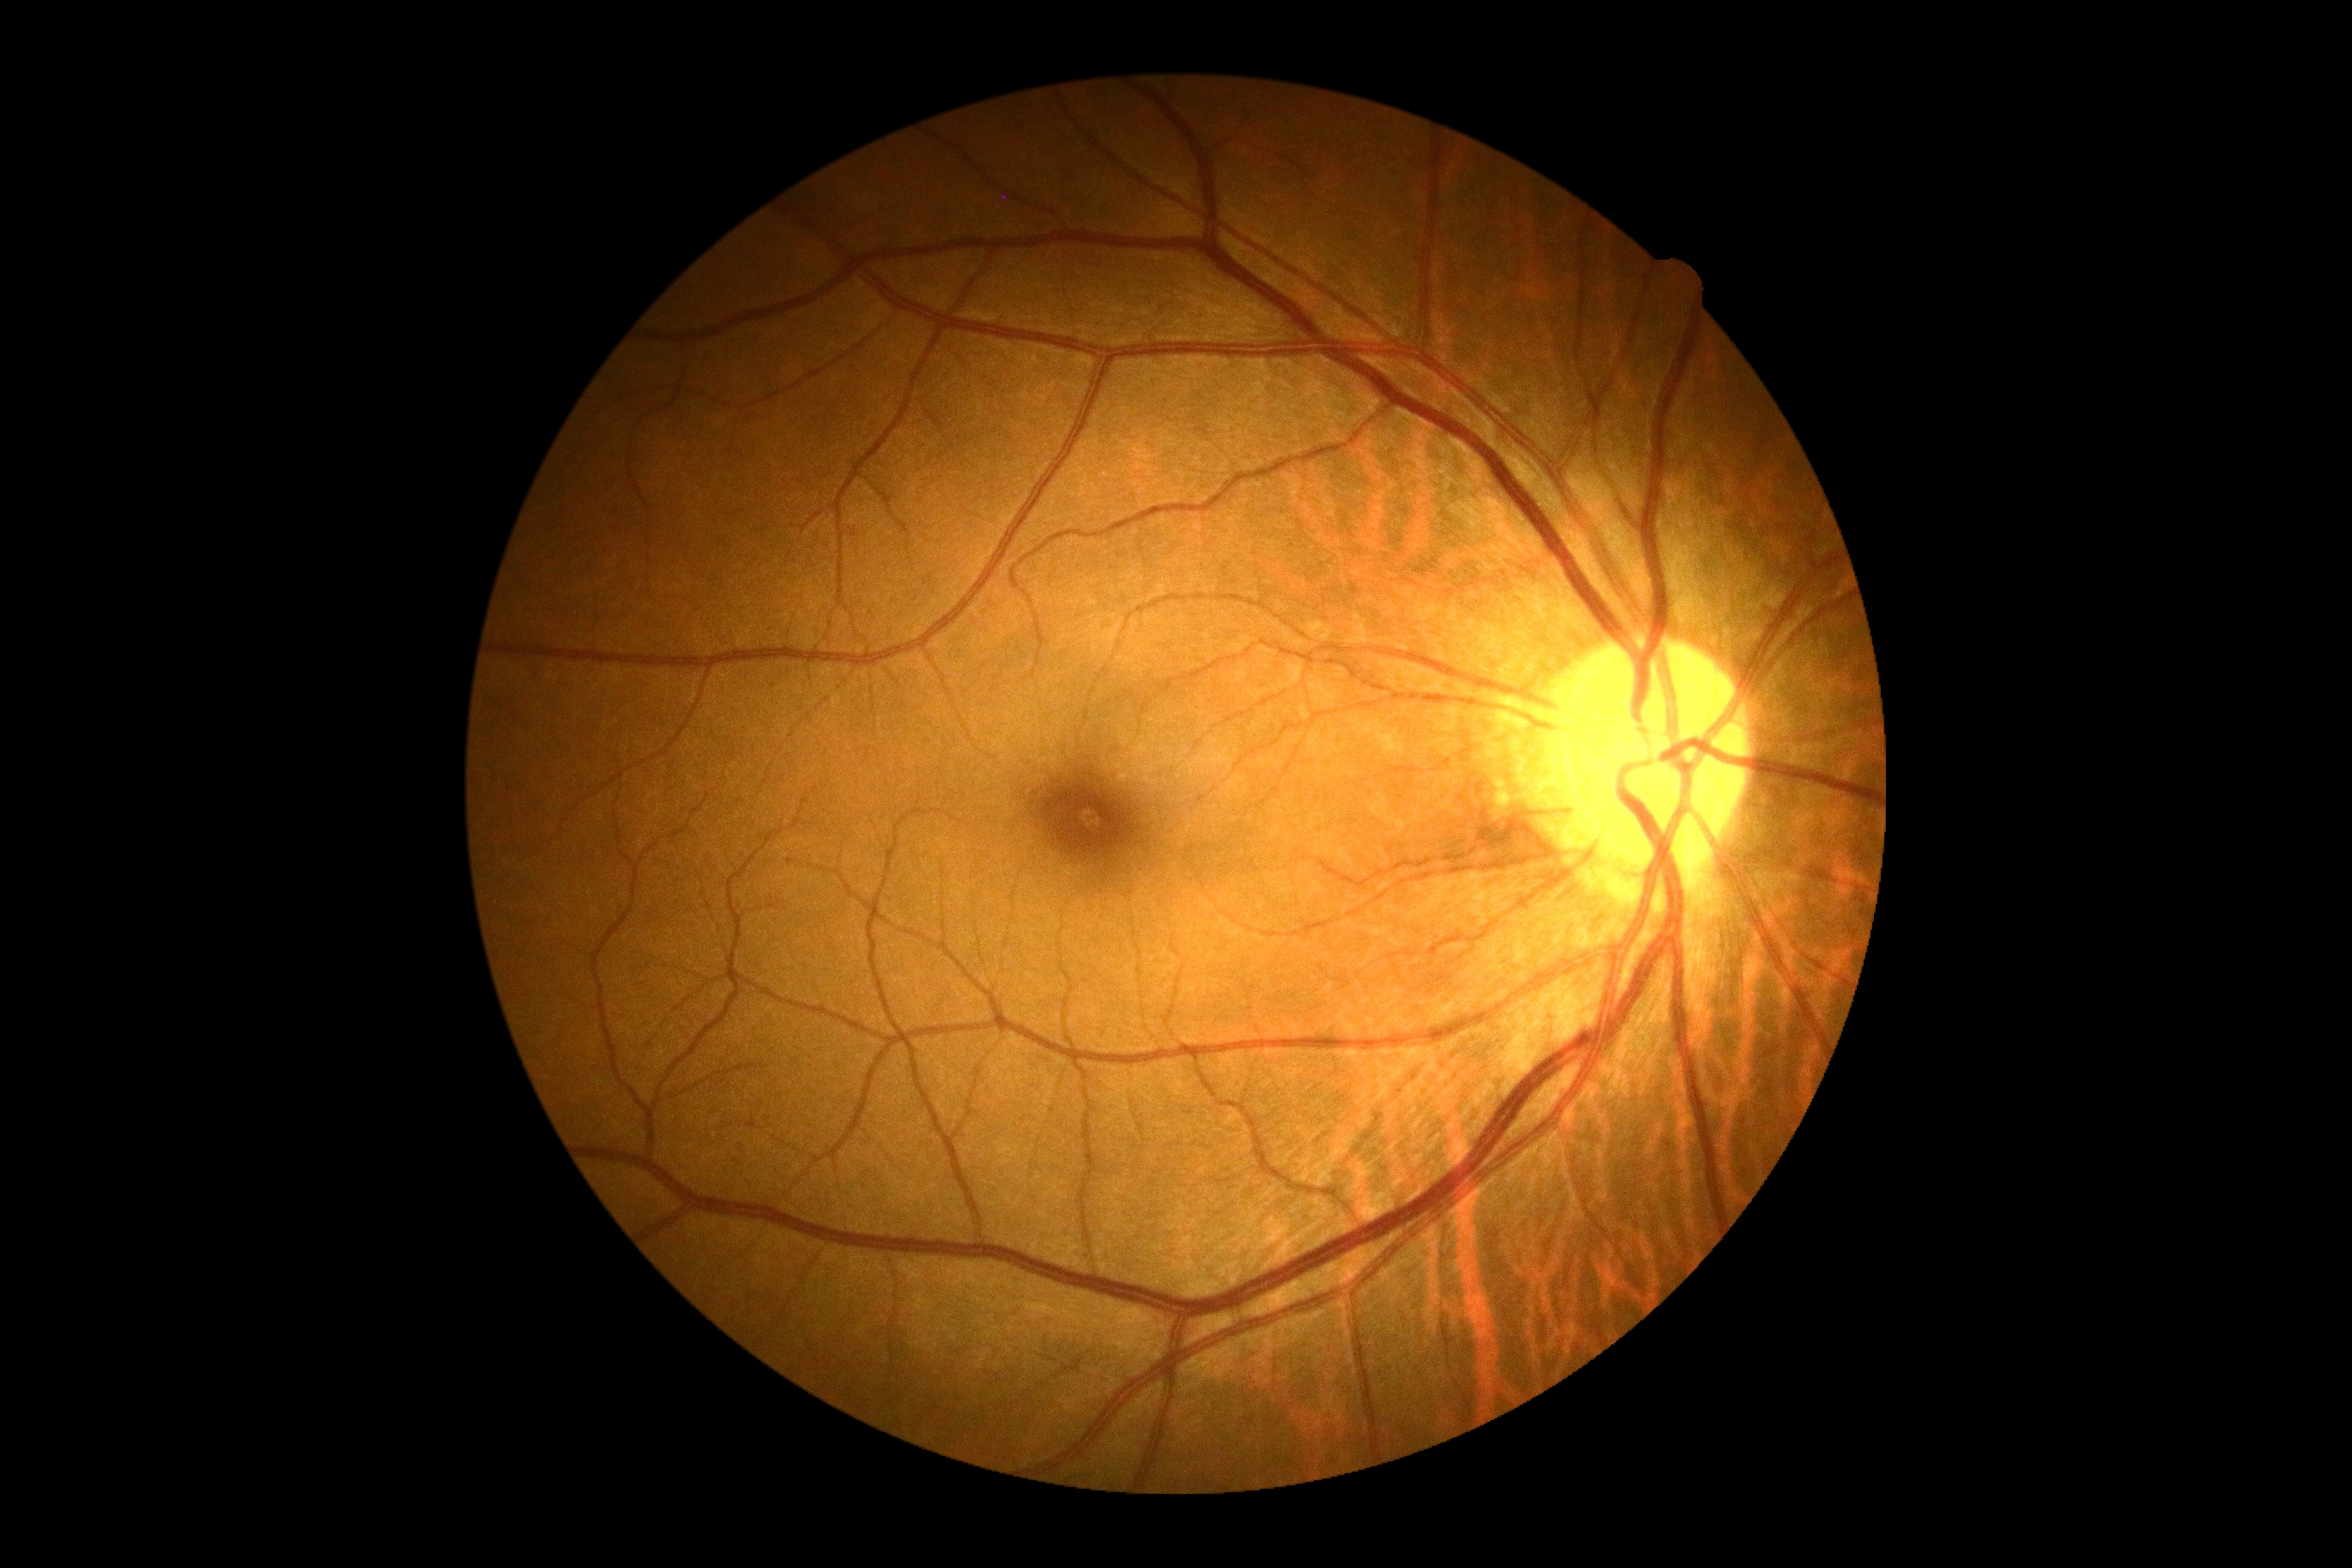
Diabetic retinopathy is 0.